Retinal fundus photograph. 1659 by 2212 pixels
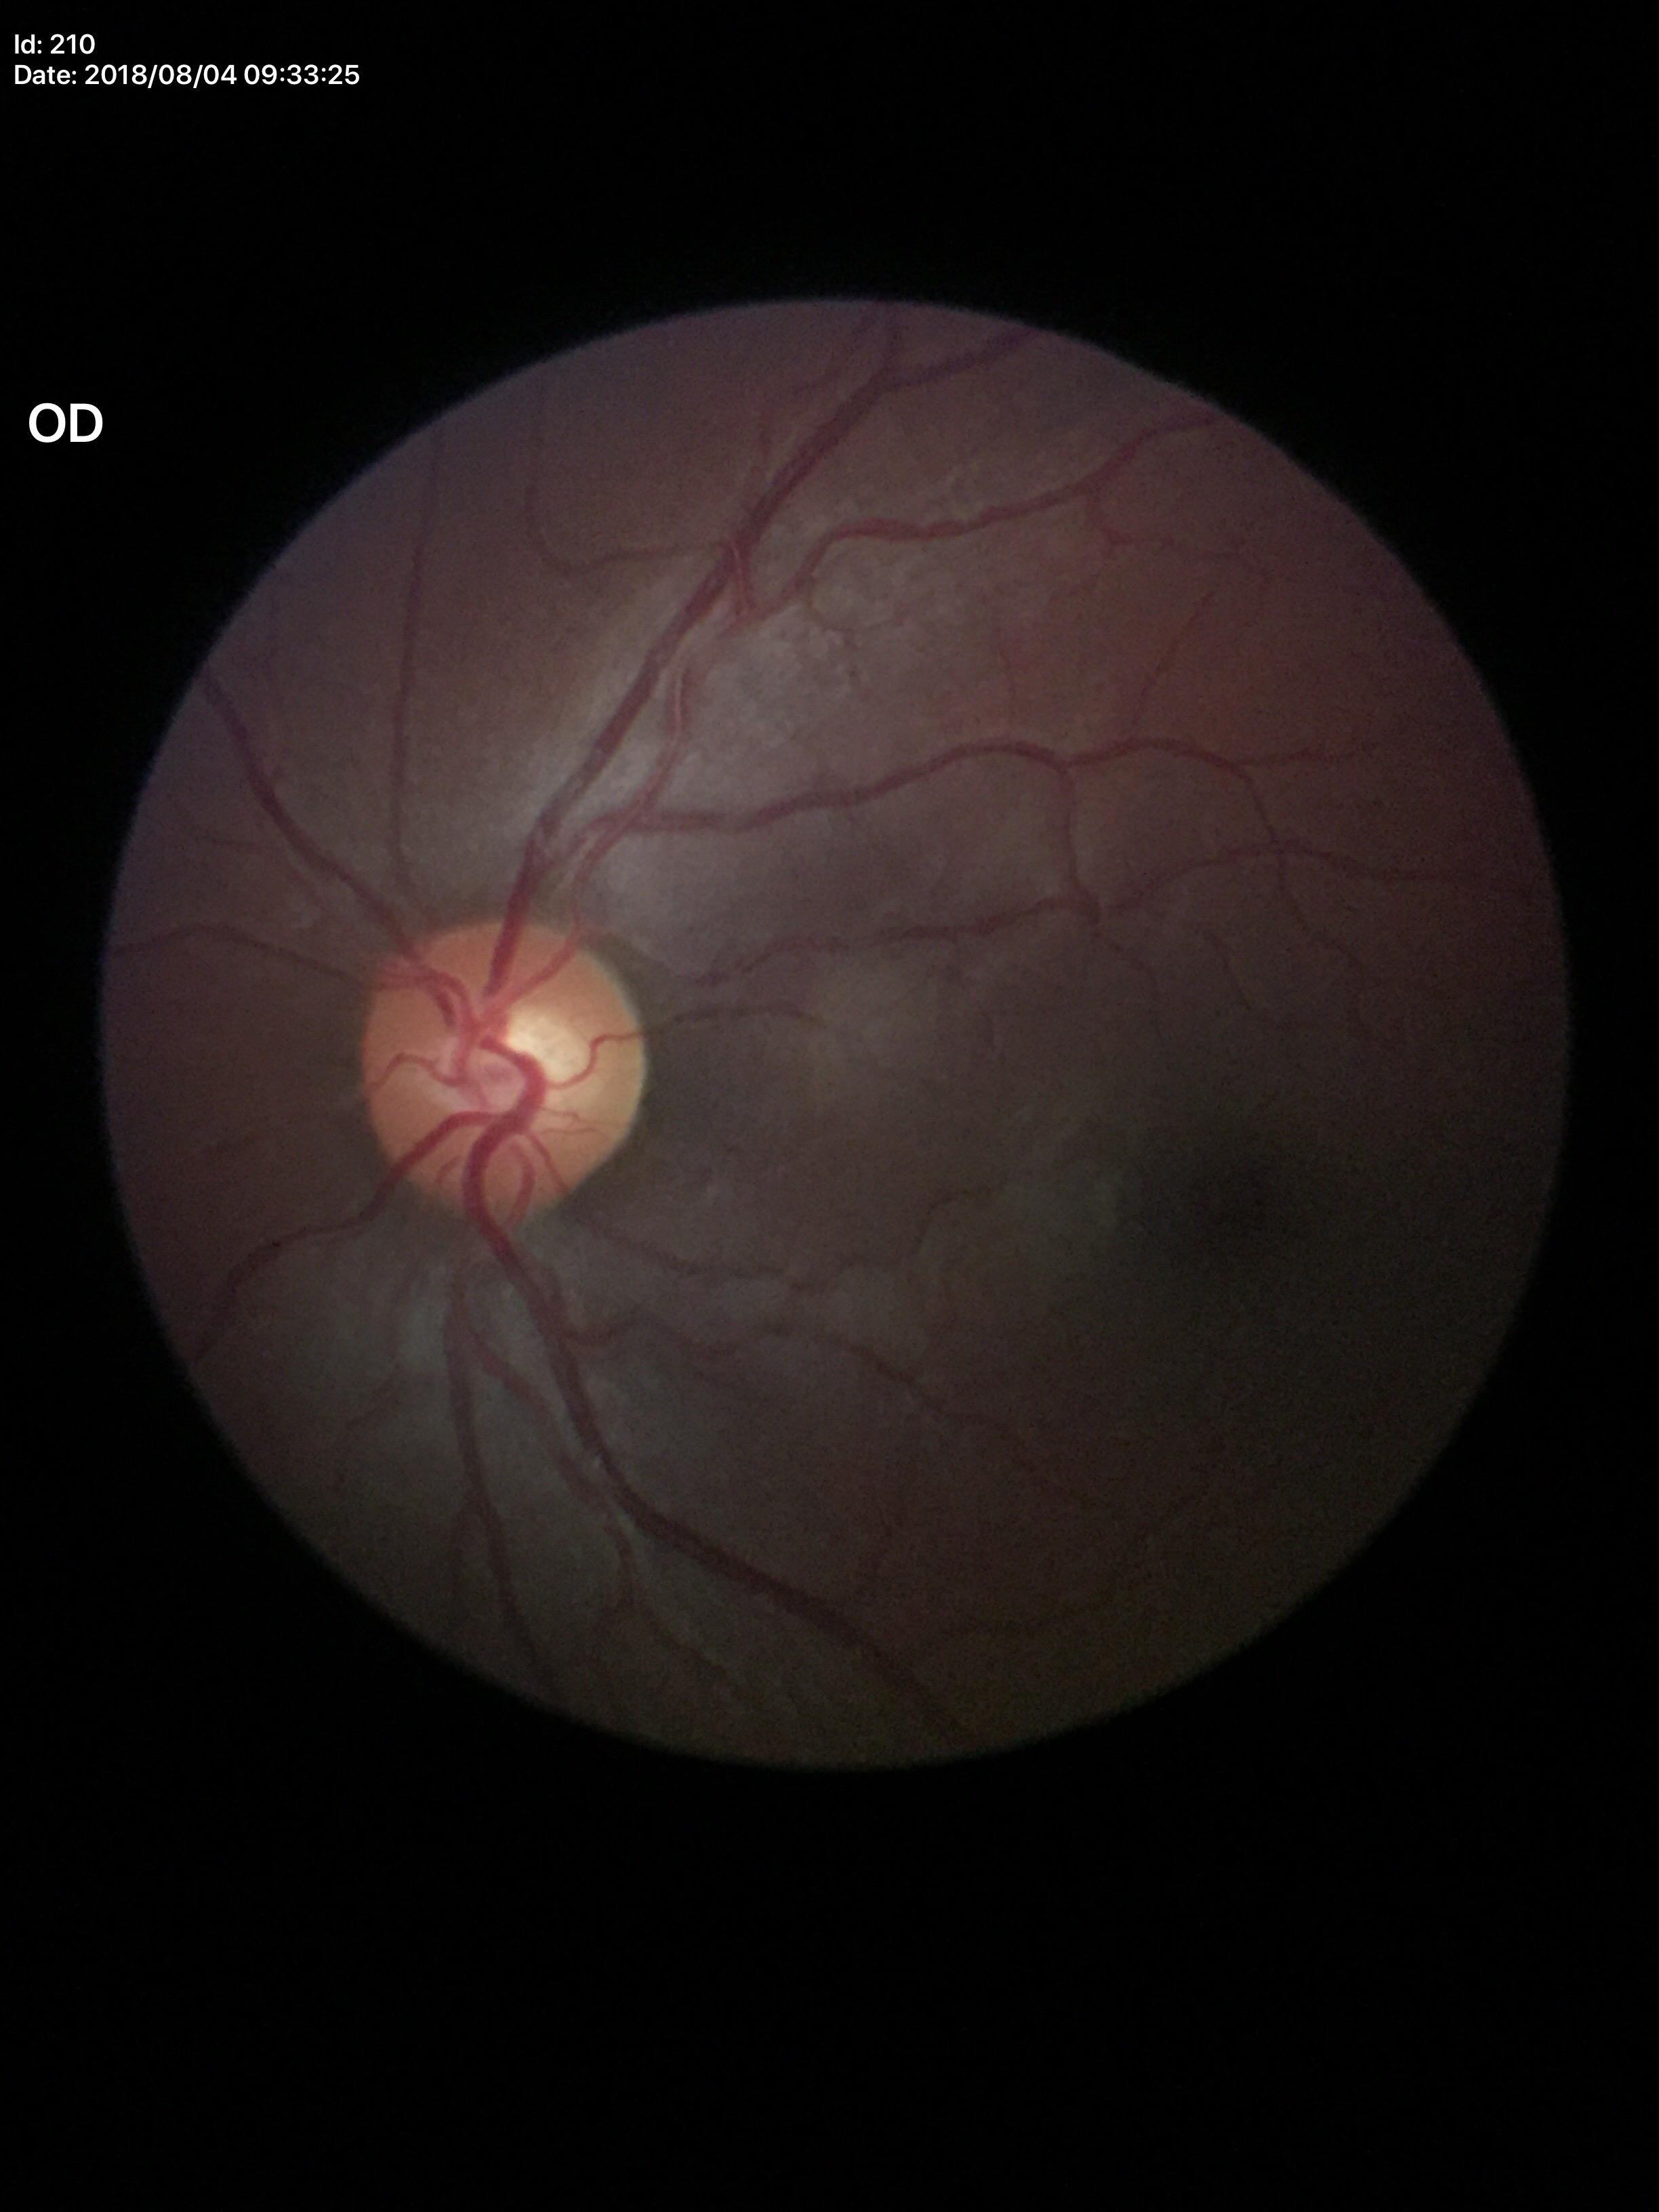

glaucoma_decision: no suspicious findings
vcdr: 0.51